Color fundus photograph, image size 240x240:
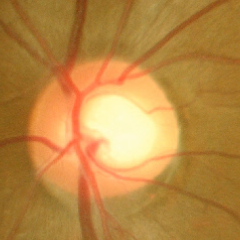 No glaucomatous changes.